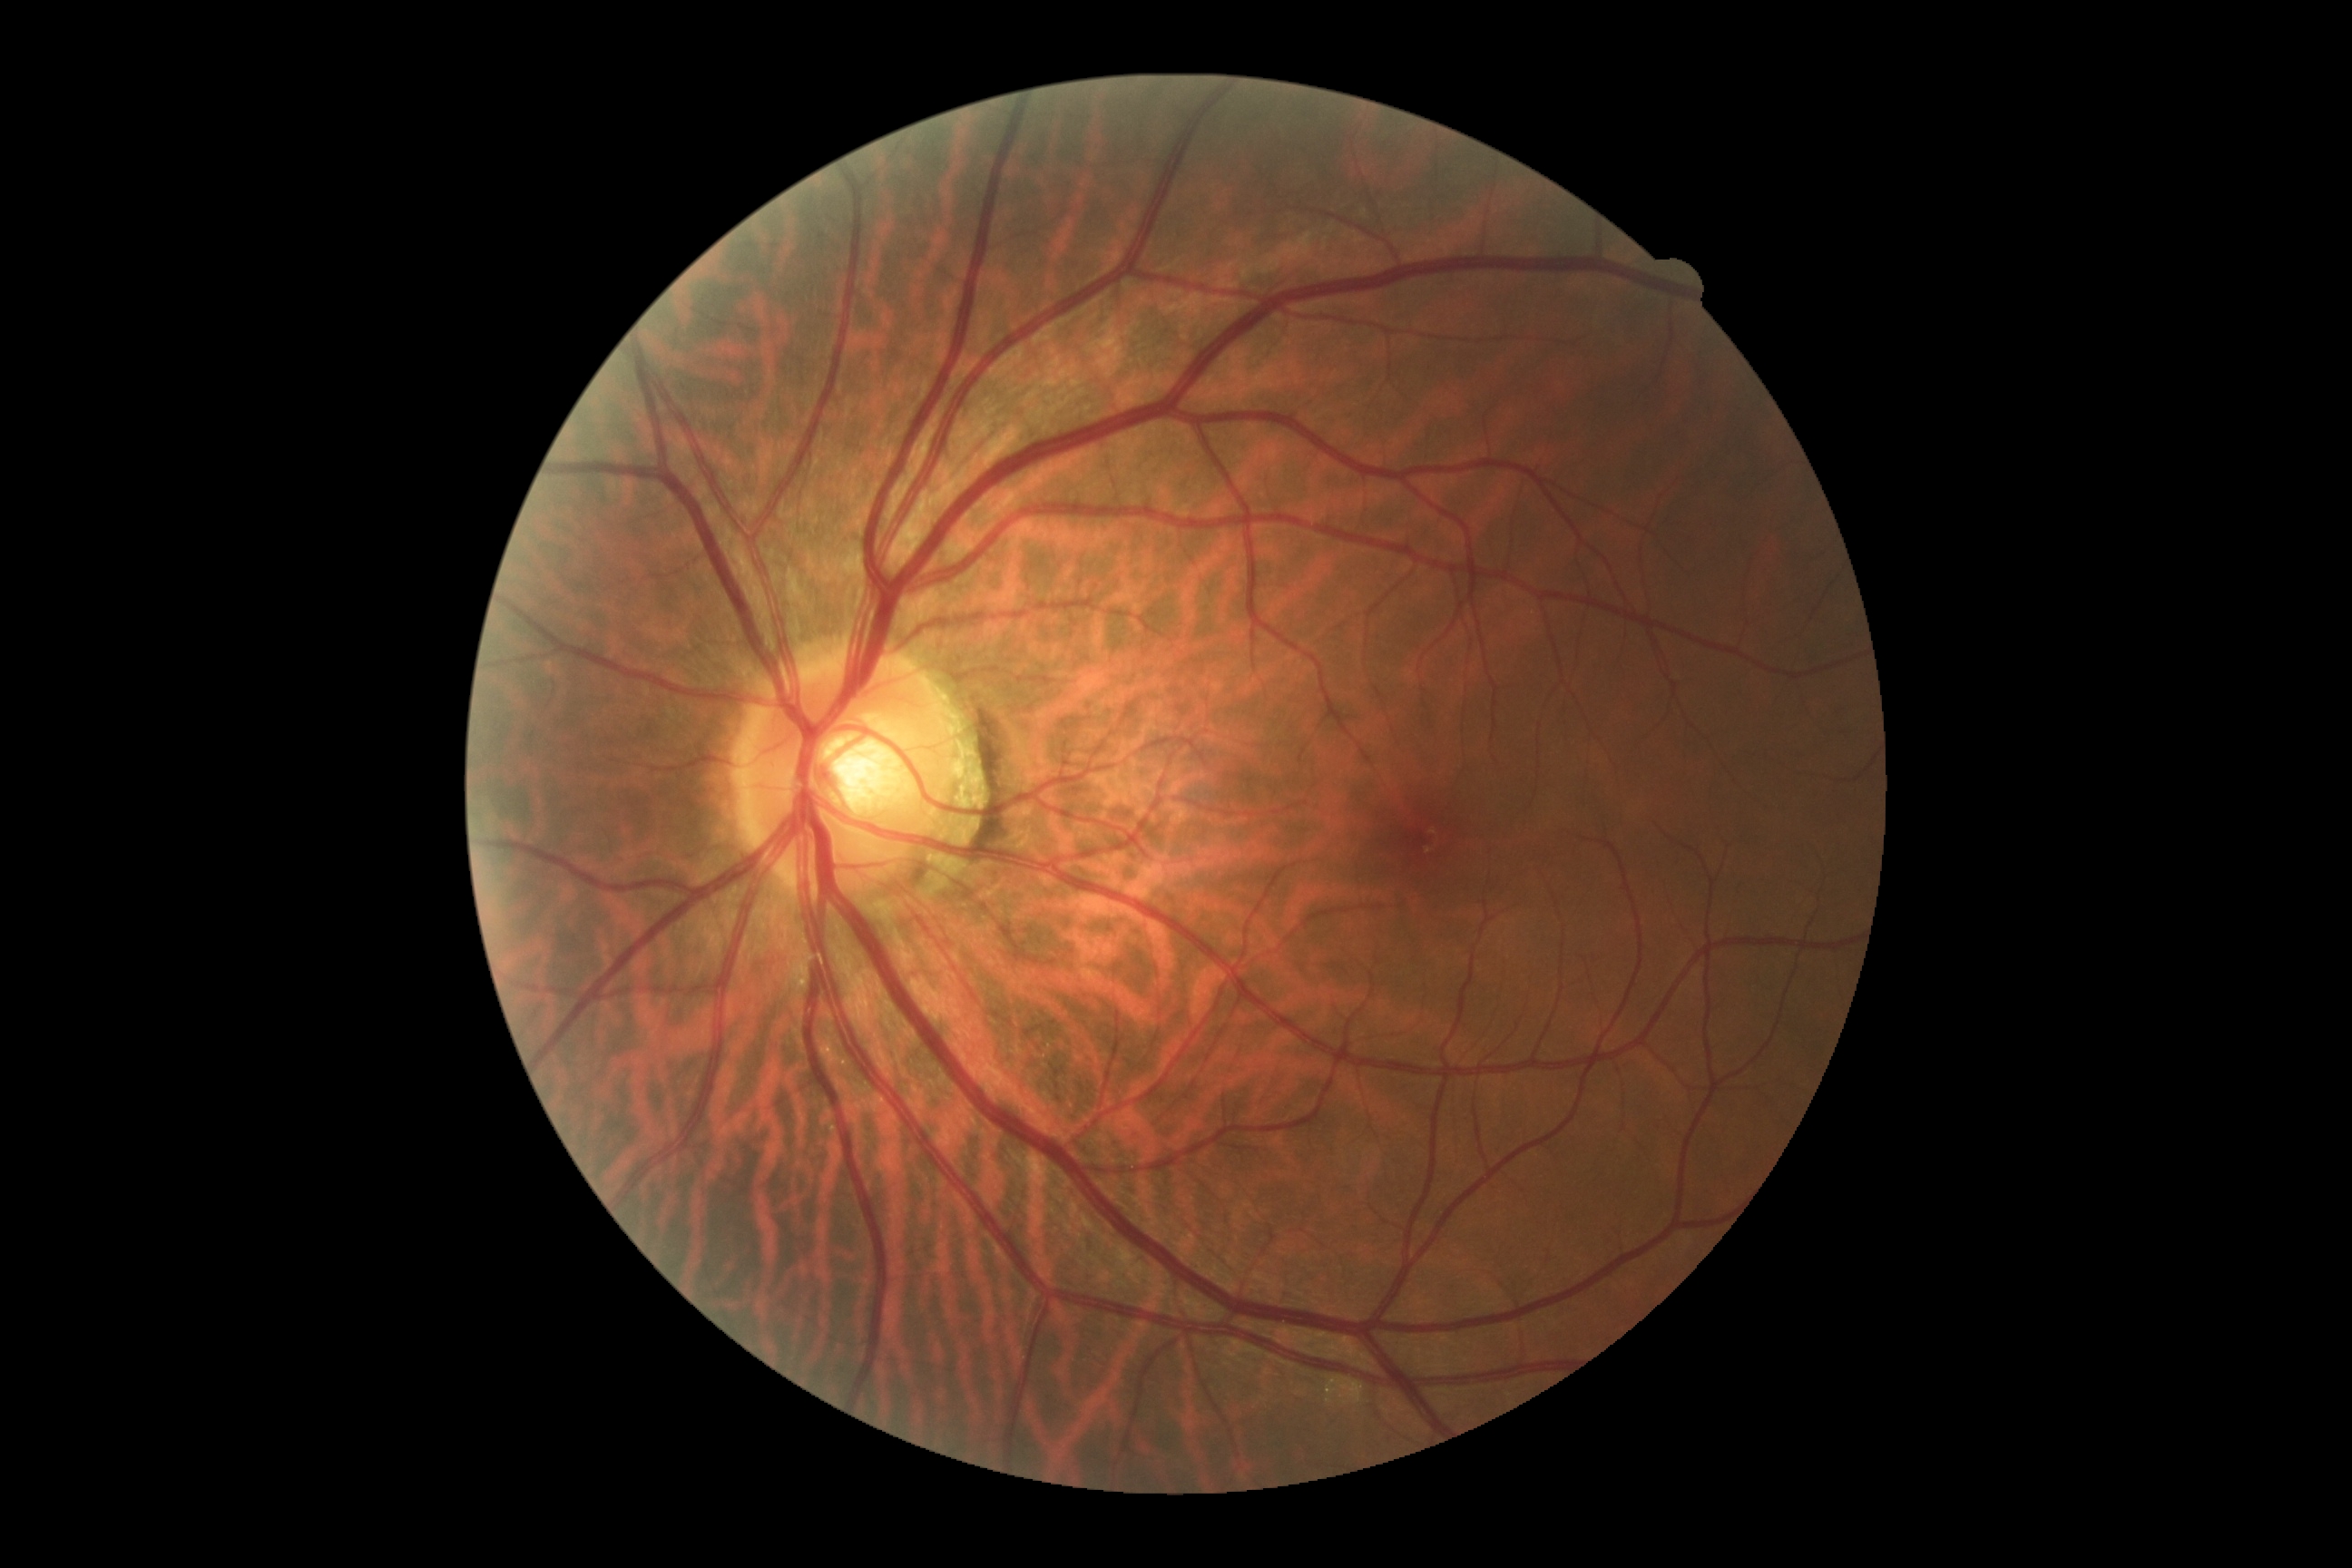
Annotations:
• DR — grade 0